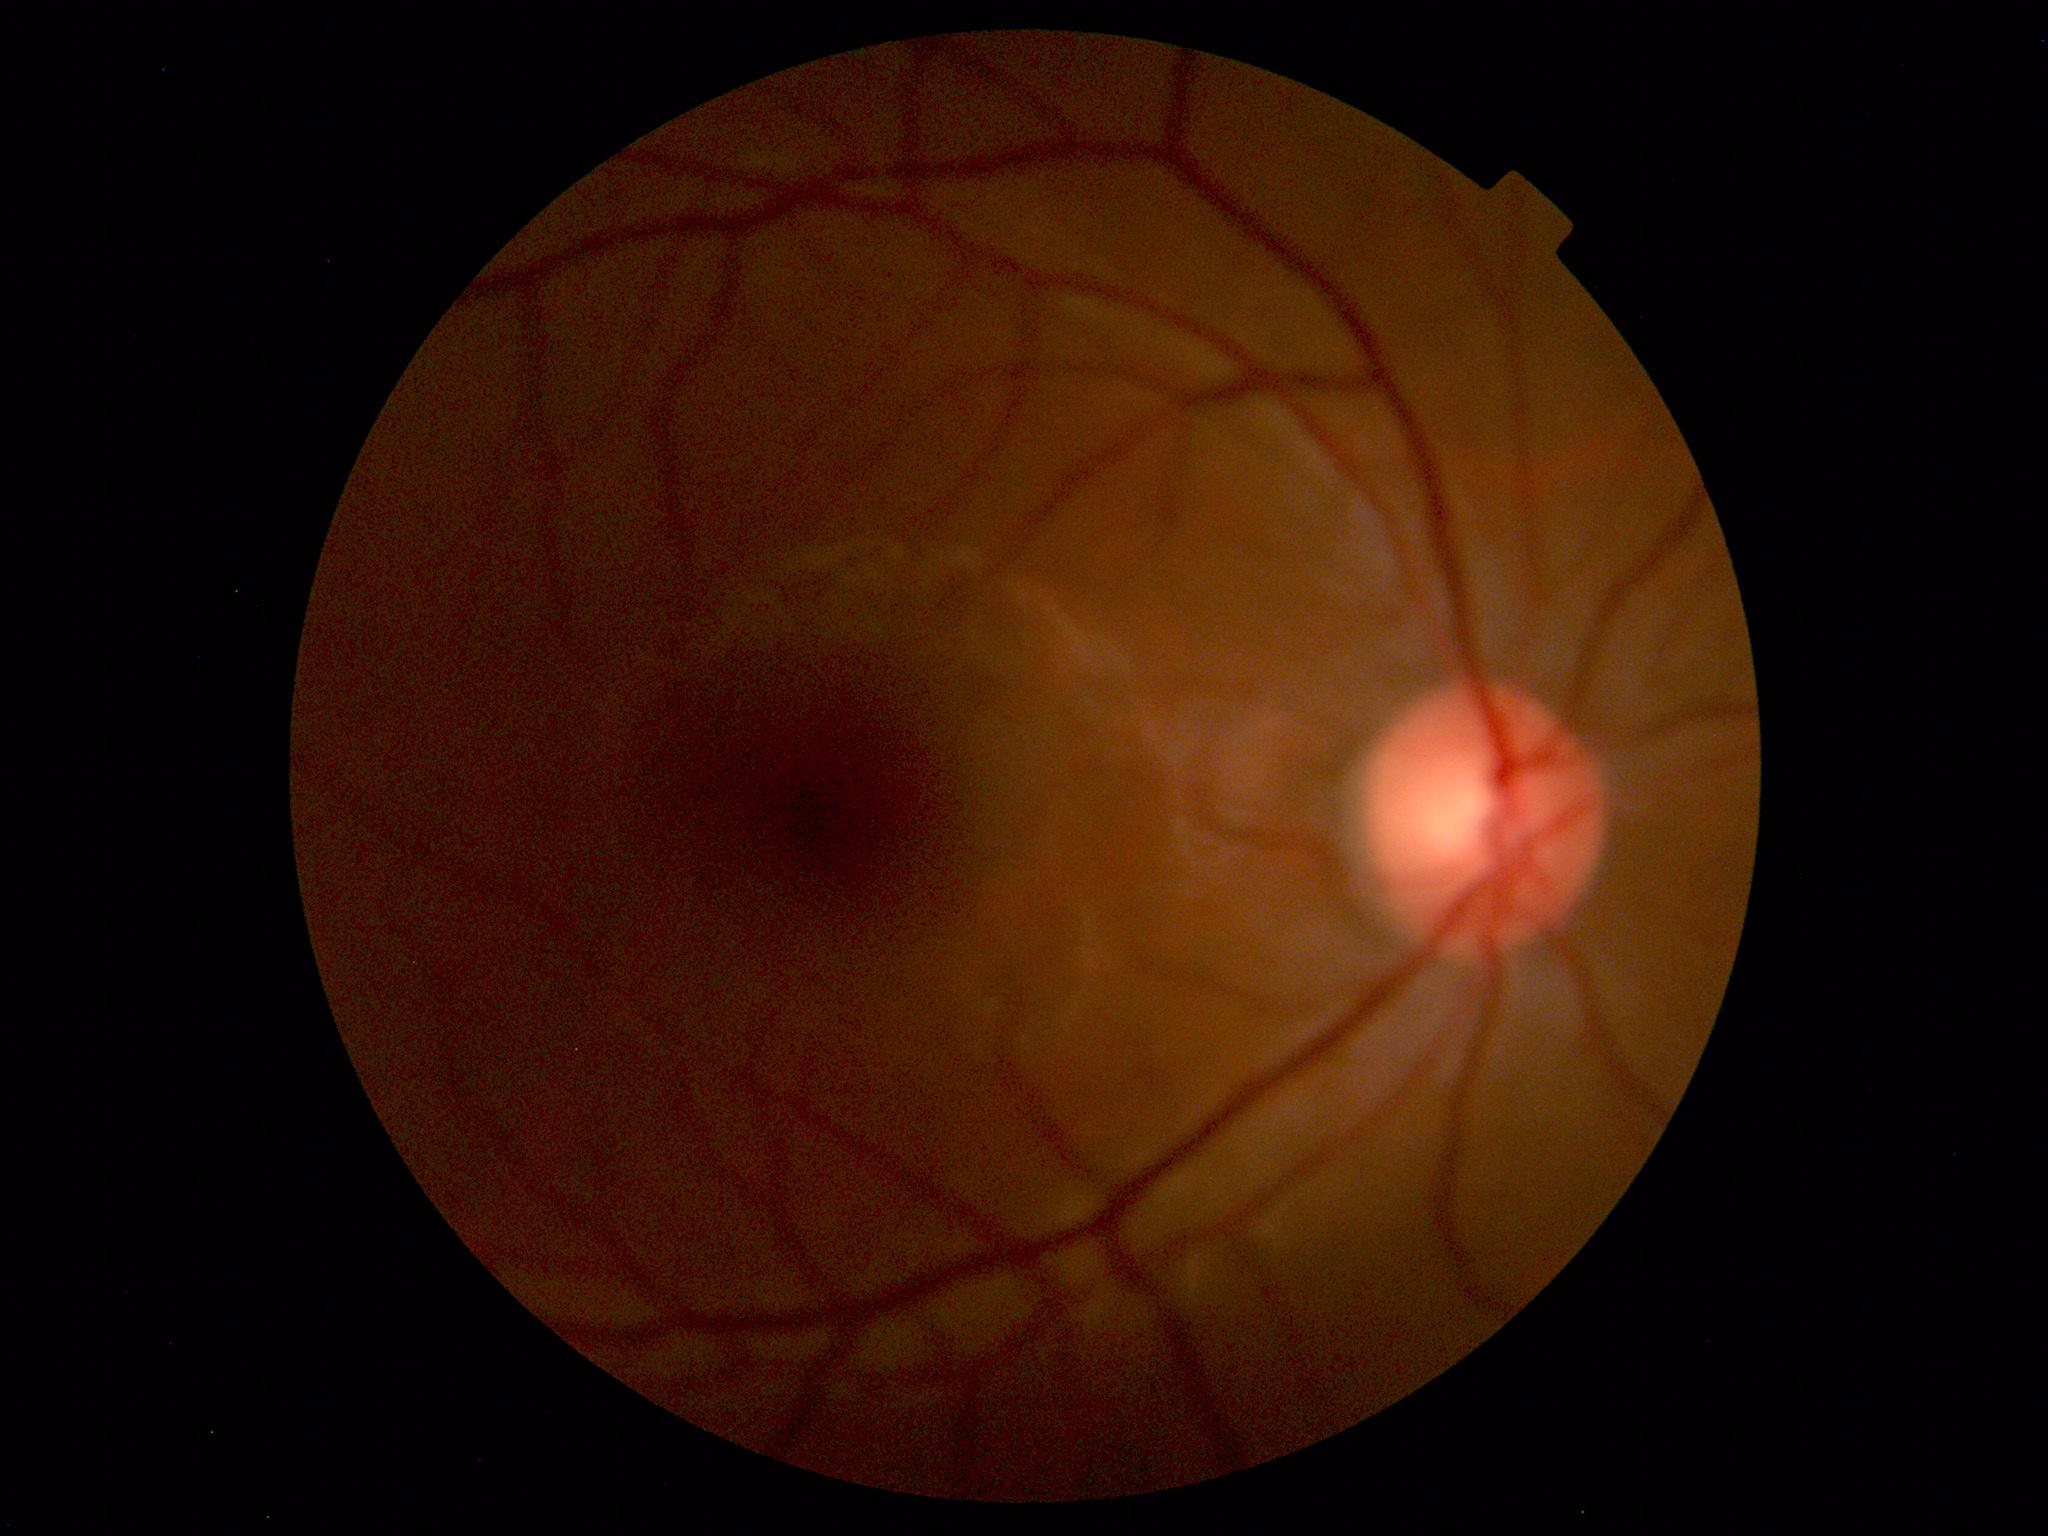
Normal fundus. No pathology identified.